No pharmacologic dilation: 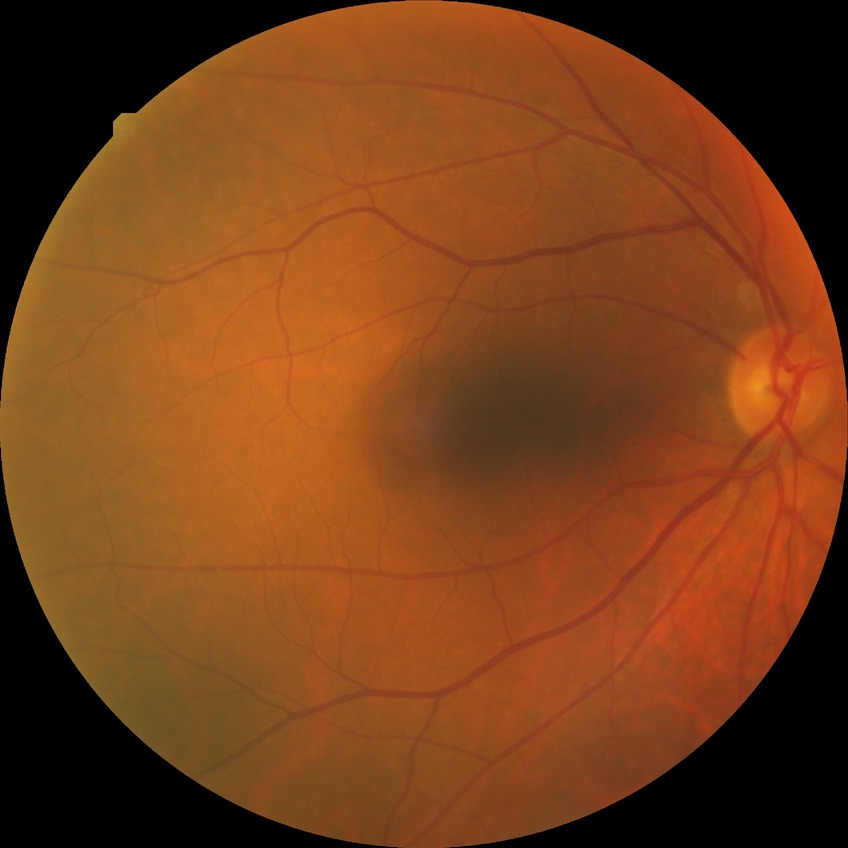
DR stage is NDR.
No diabetic retinal disease findings.